848 by 848 pixels, acquired with a NIDEK AFC-230, 45° field of view: 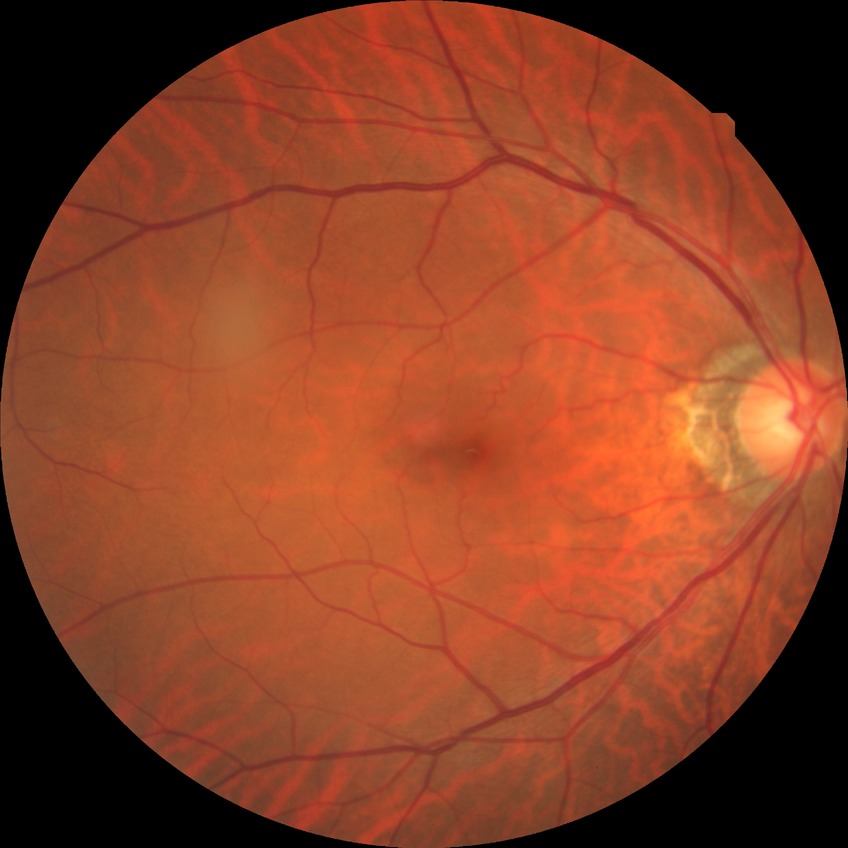
Diabetic retinopathy (DR) is no diabetic retinopathy (NDR).